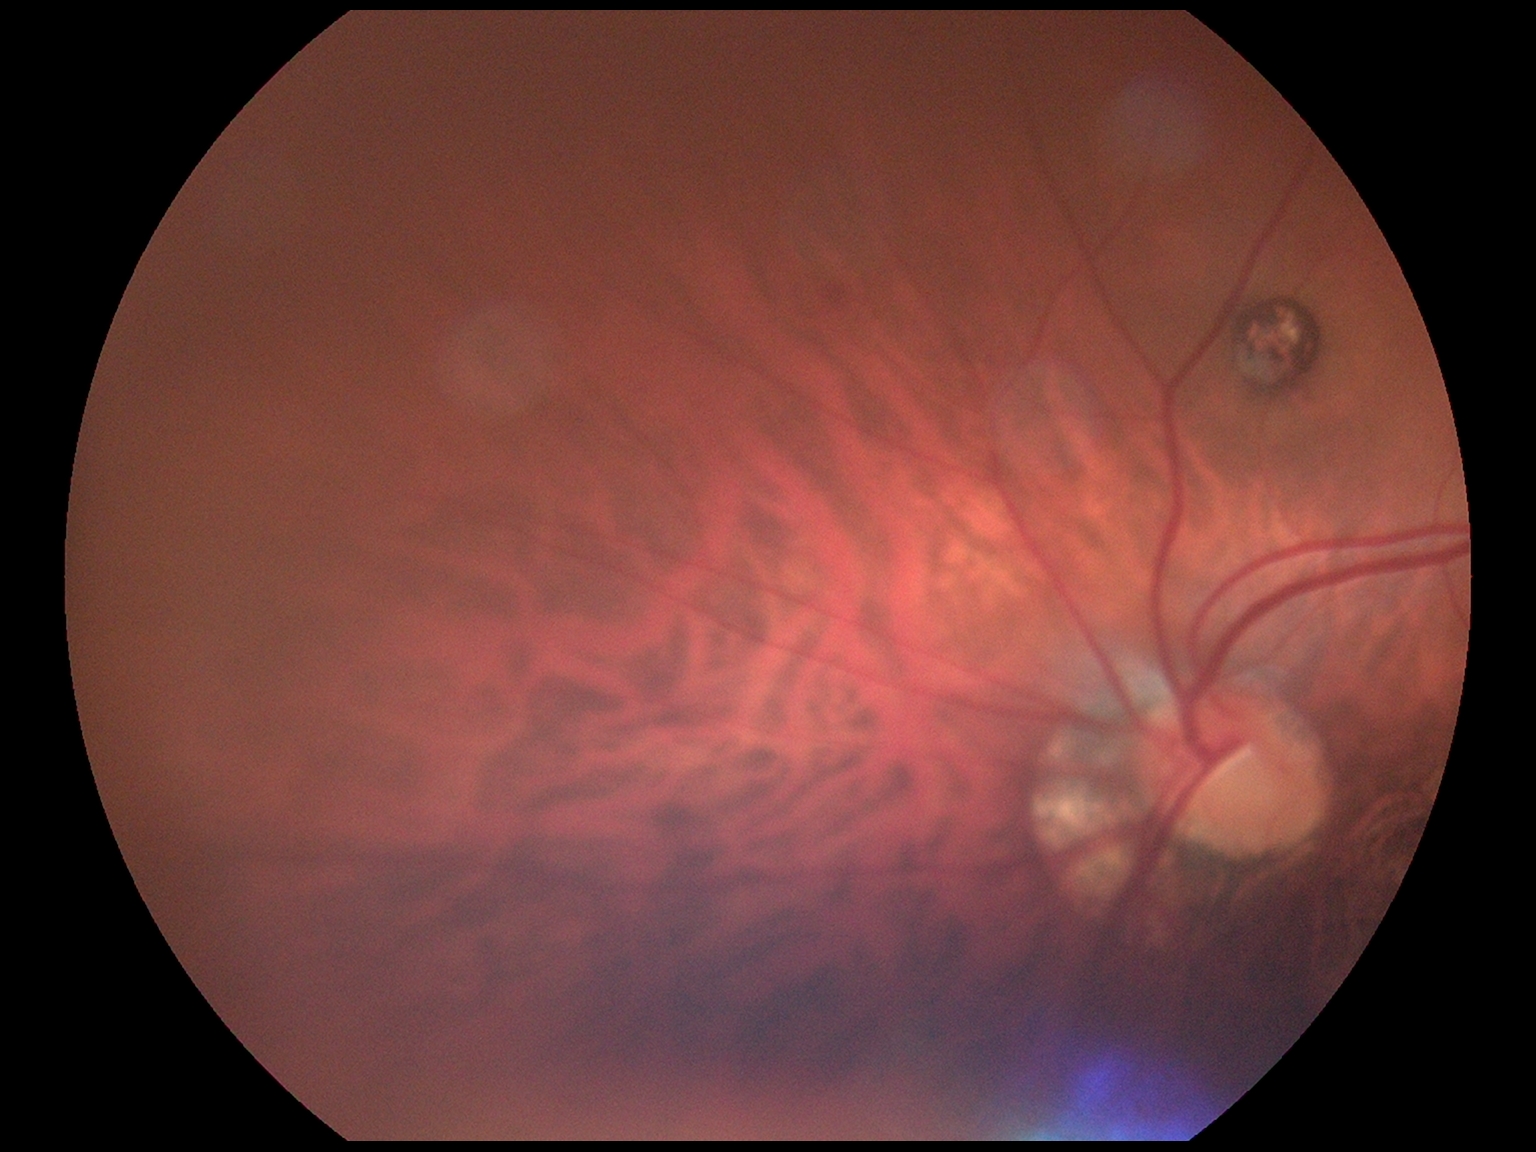

DR: 2.